Fundus photo — 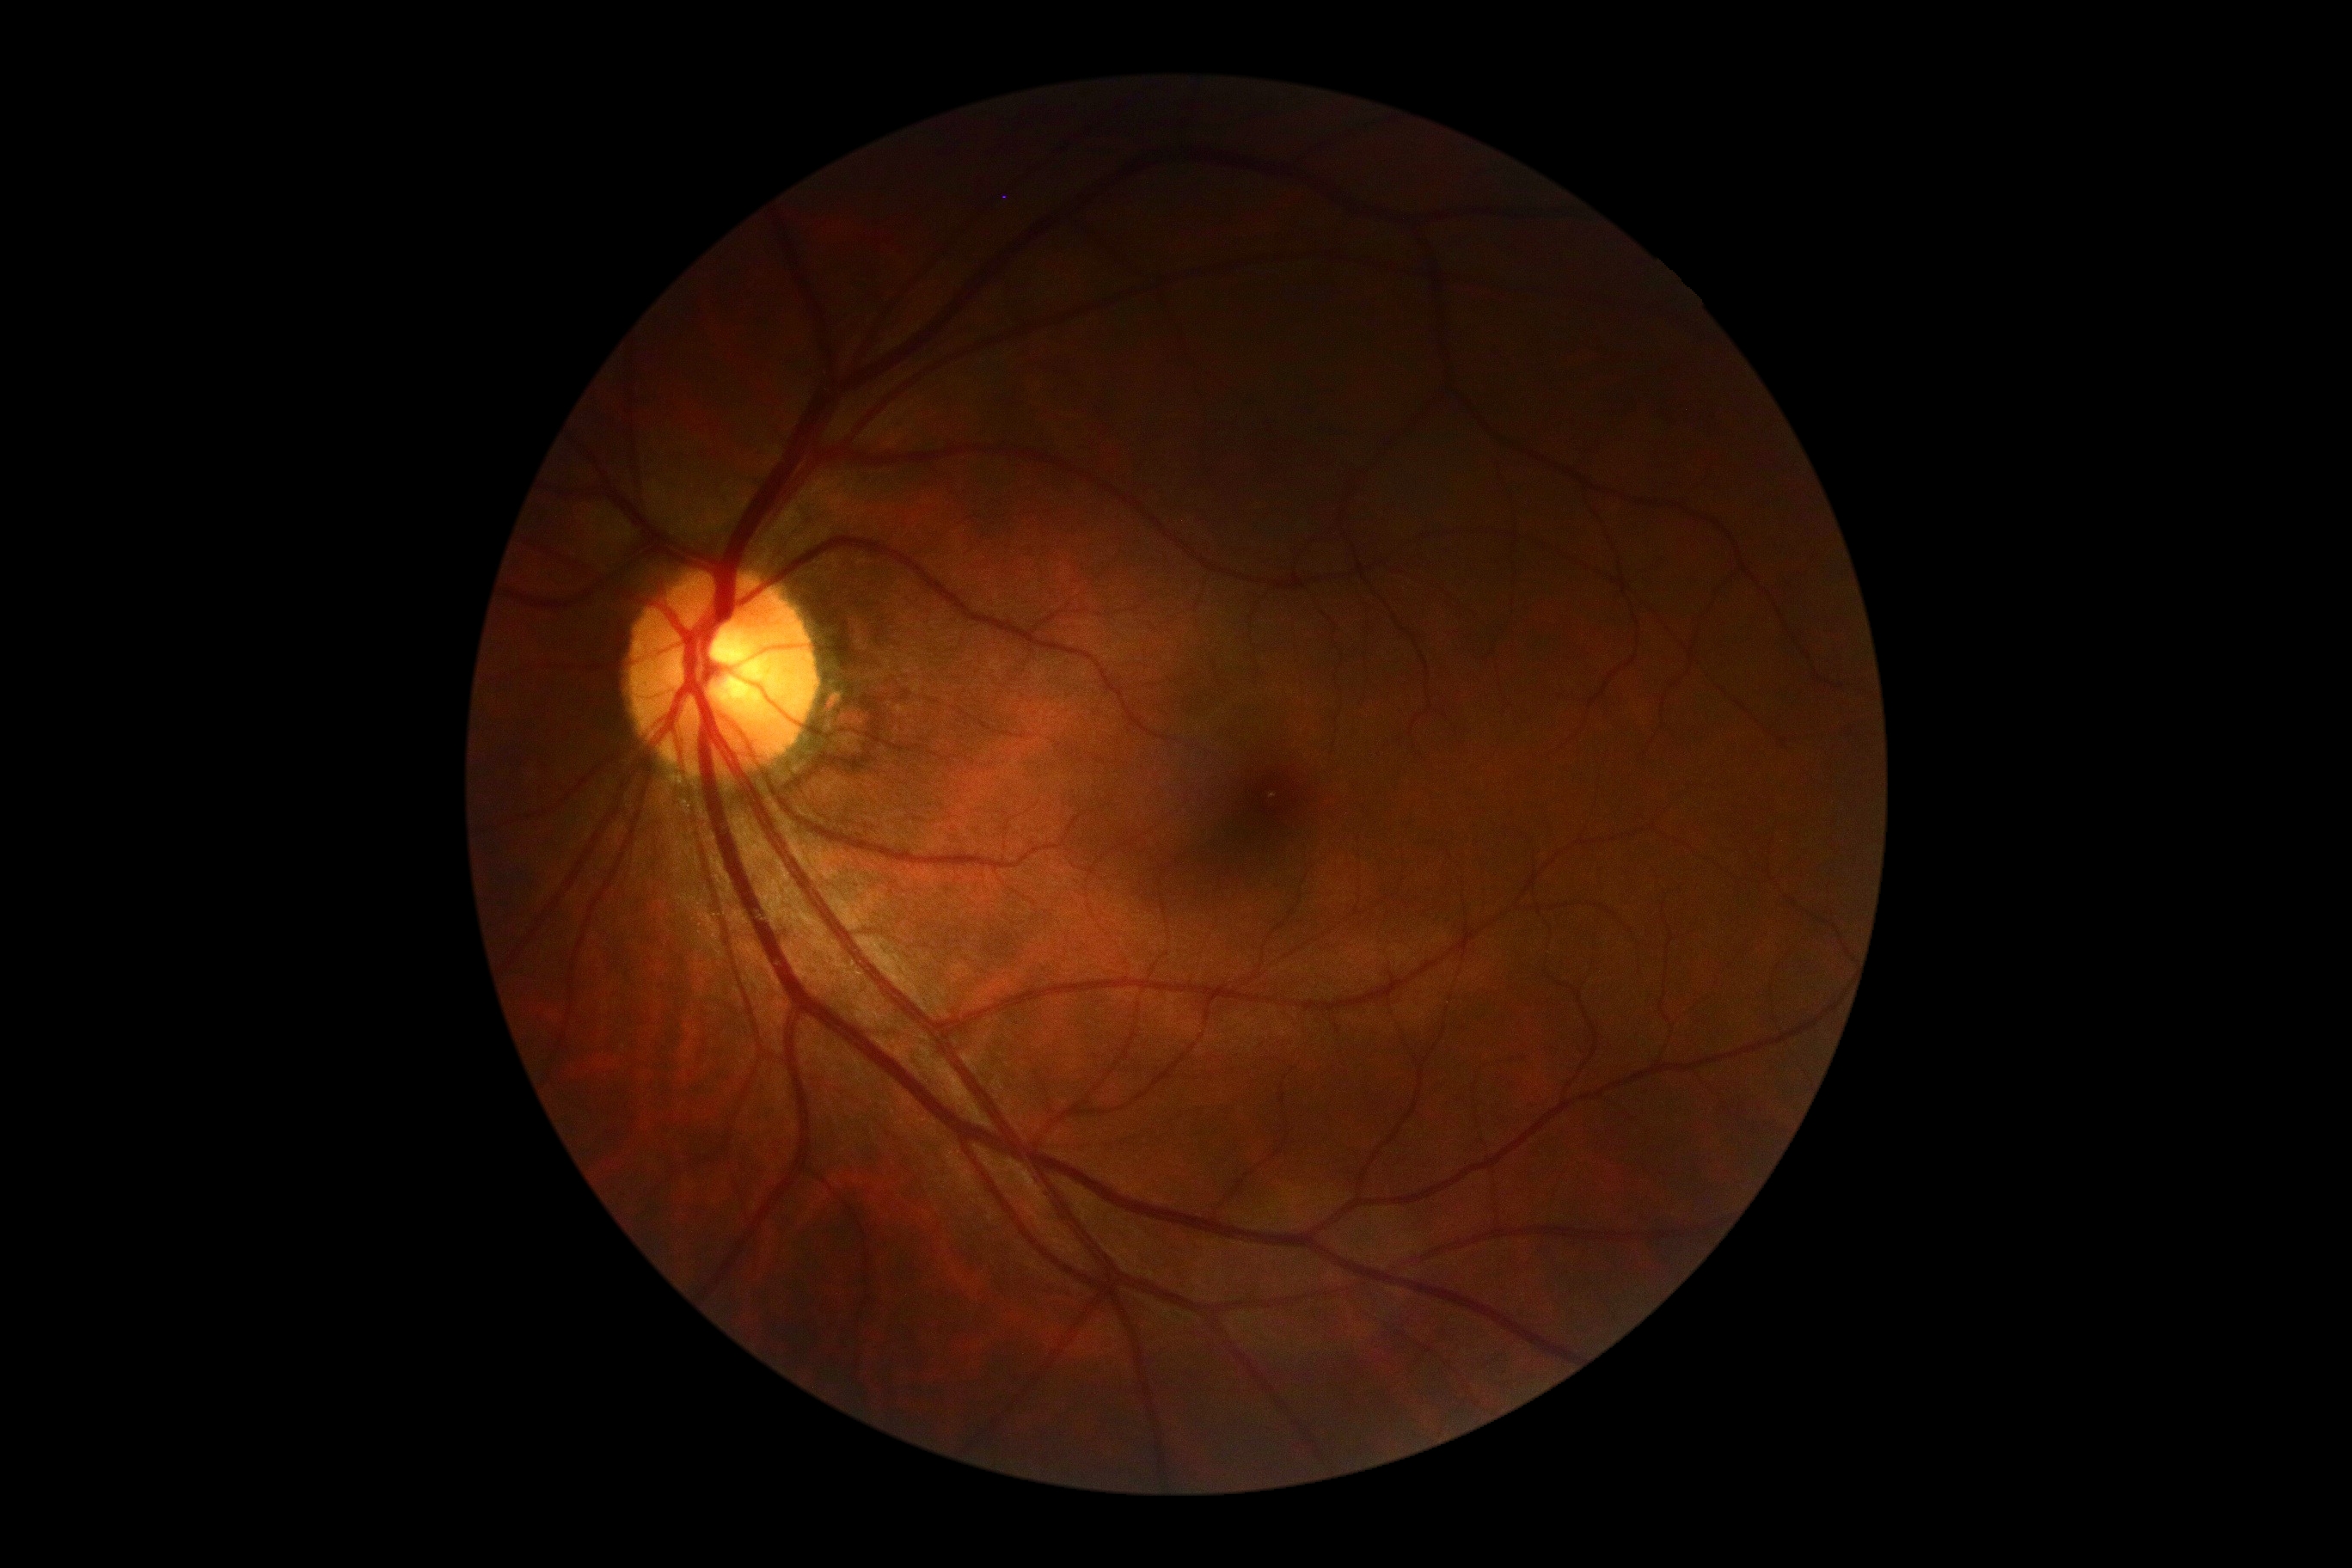
DR stage: 0. No apparent diabetic retinopathy.